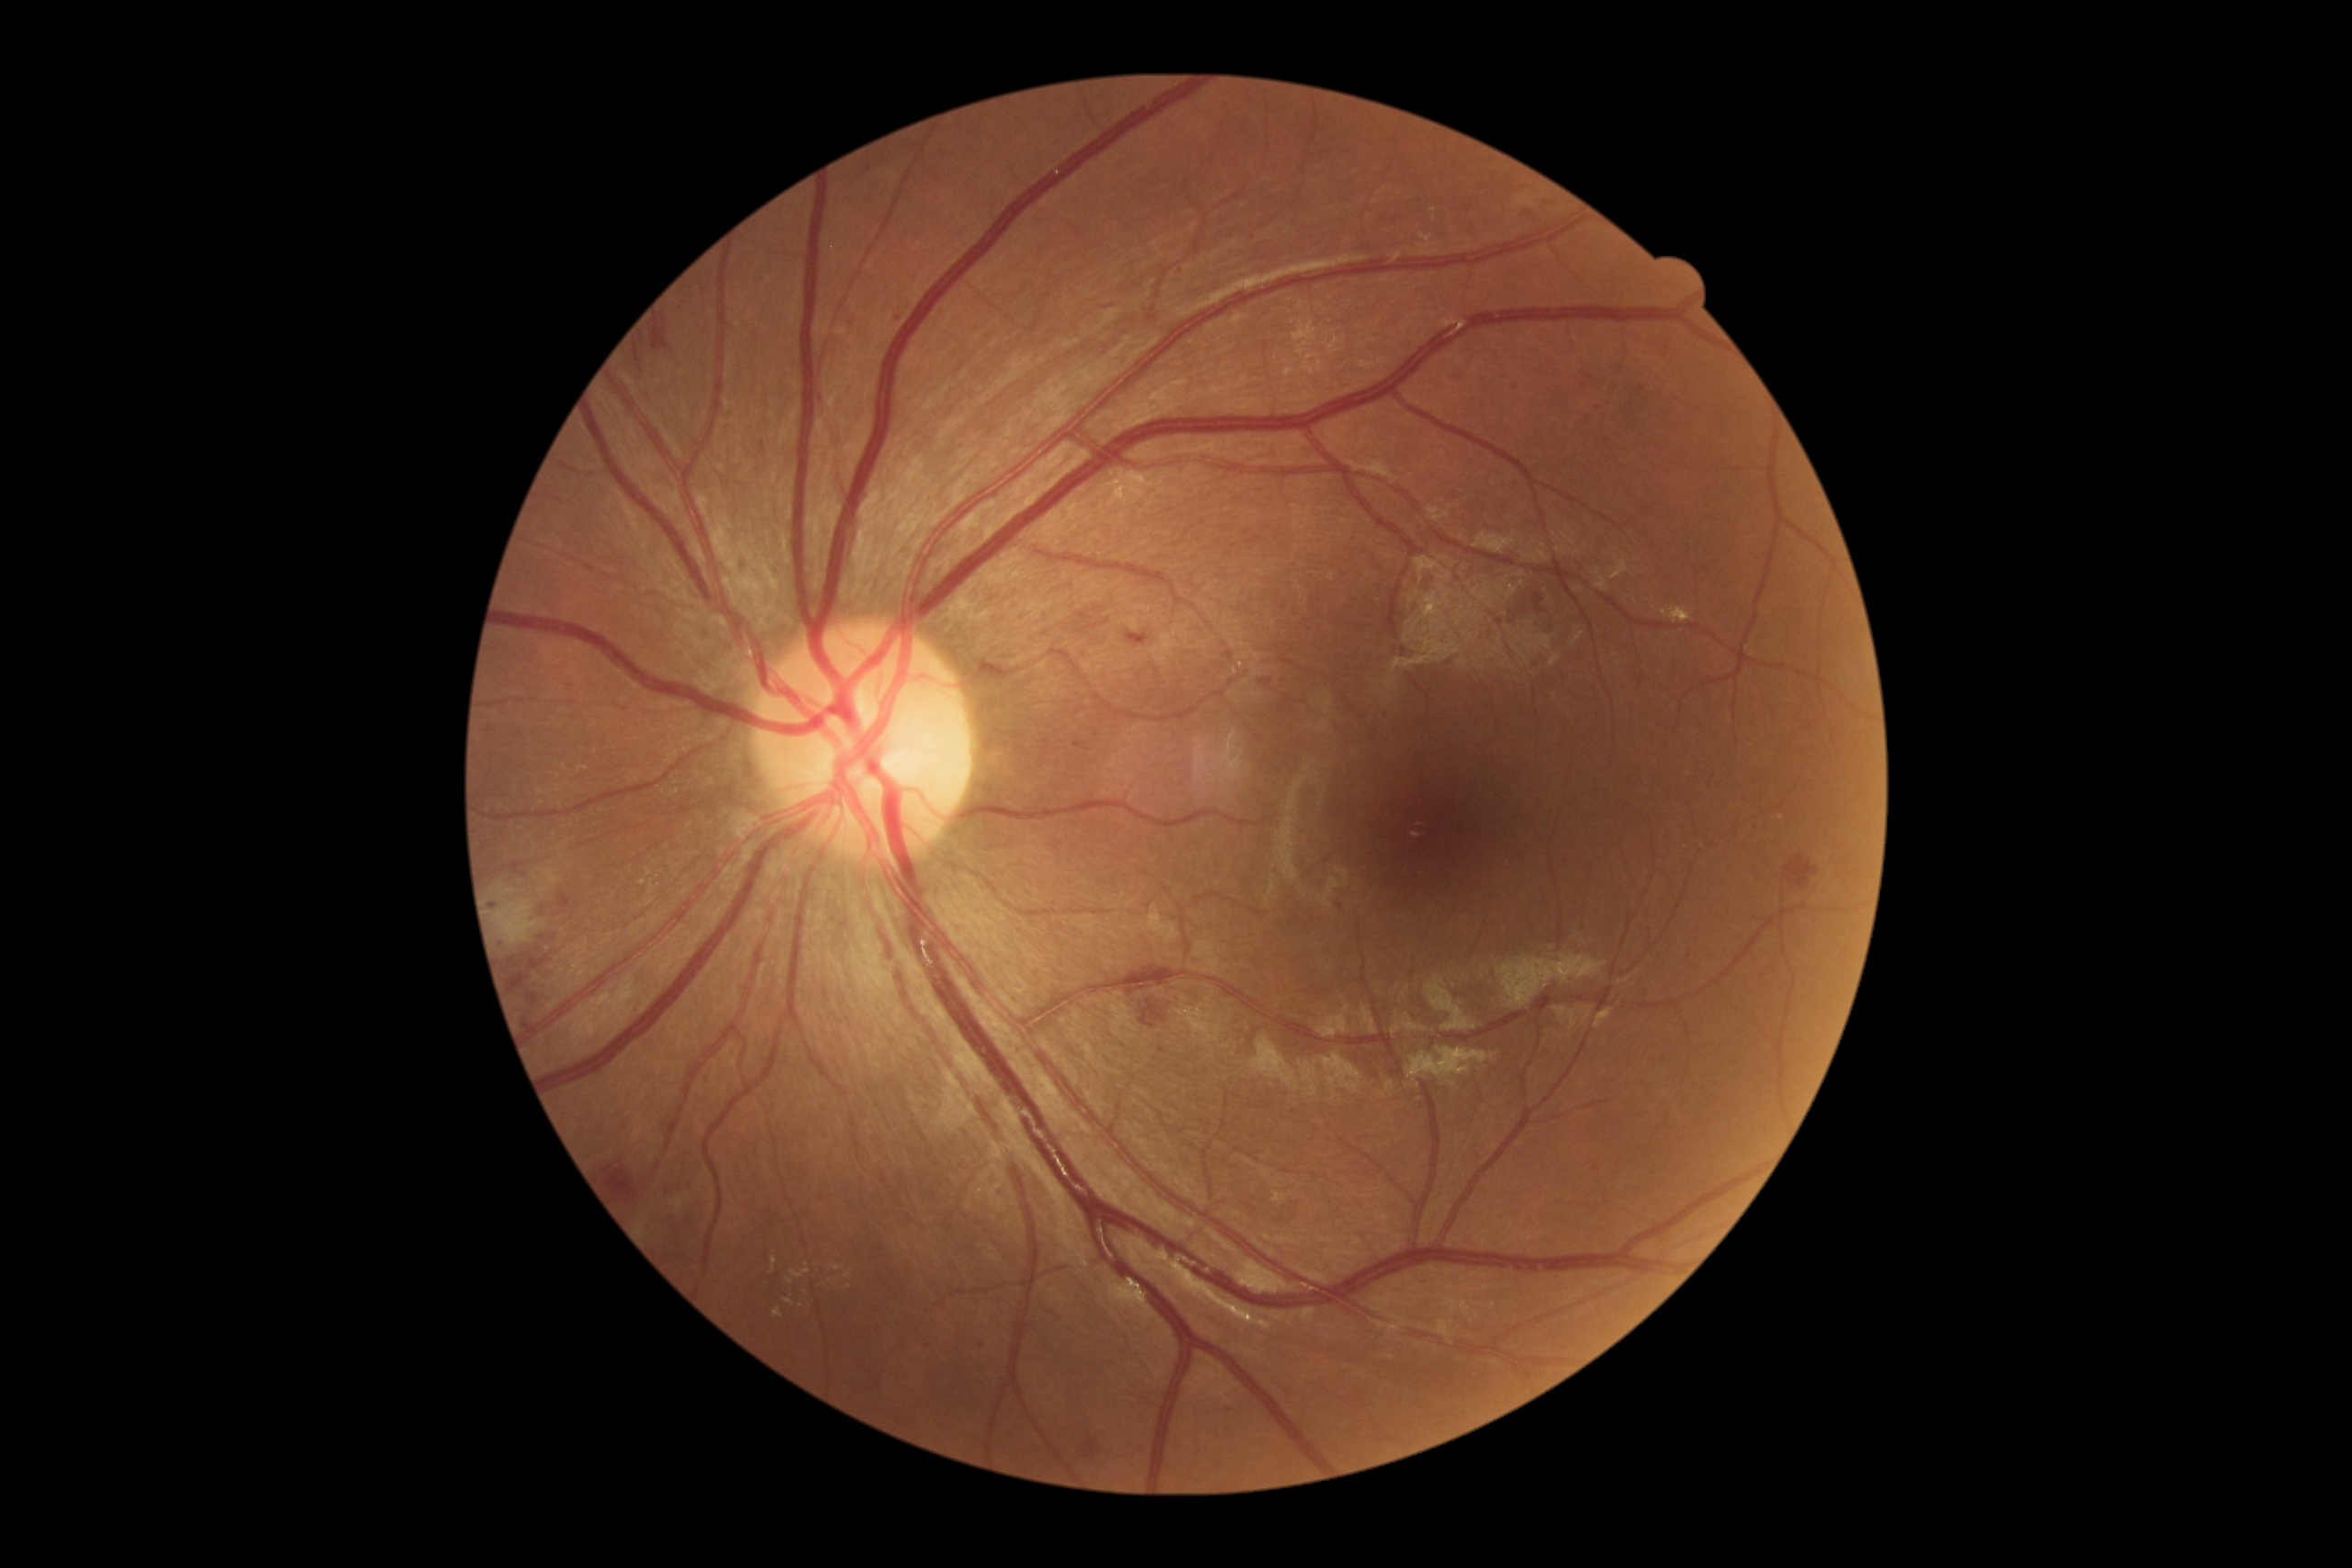 diabetic retinopathy (DR): grade 2 (moderate NPDR) | DR class: non-proliferative diabetic retinopathy.